Posterior pole color fundus photograph, no pharmacologic dilation
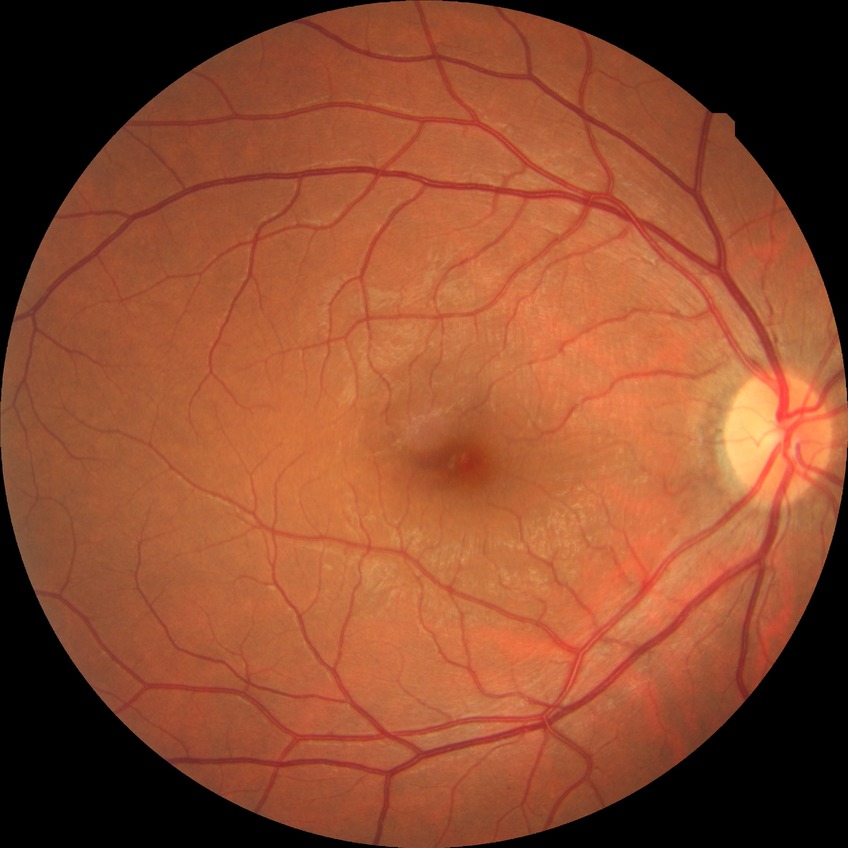

Diabetic retinopathy (DR): simple diabetic retinopathy (SDR).